Posterior pole color fundus photograph. Without pupil dilation. 848x848px. NIDEK AFC-230. 45° field of view
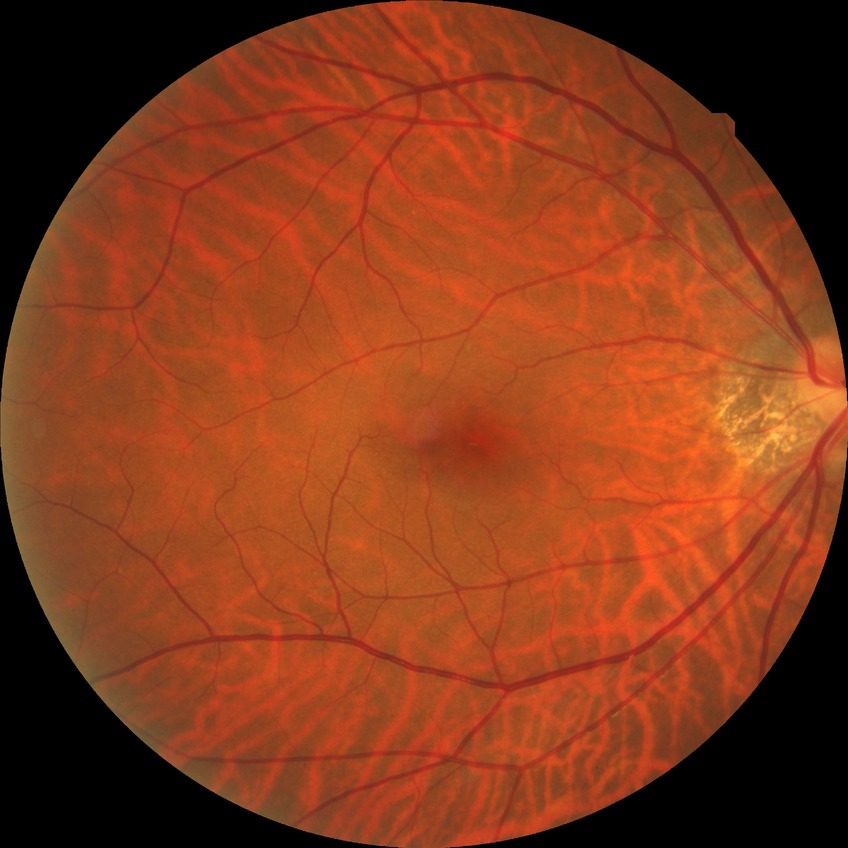

Modified Davis grading is no diabetic retinopathy.